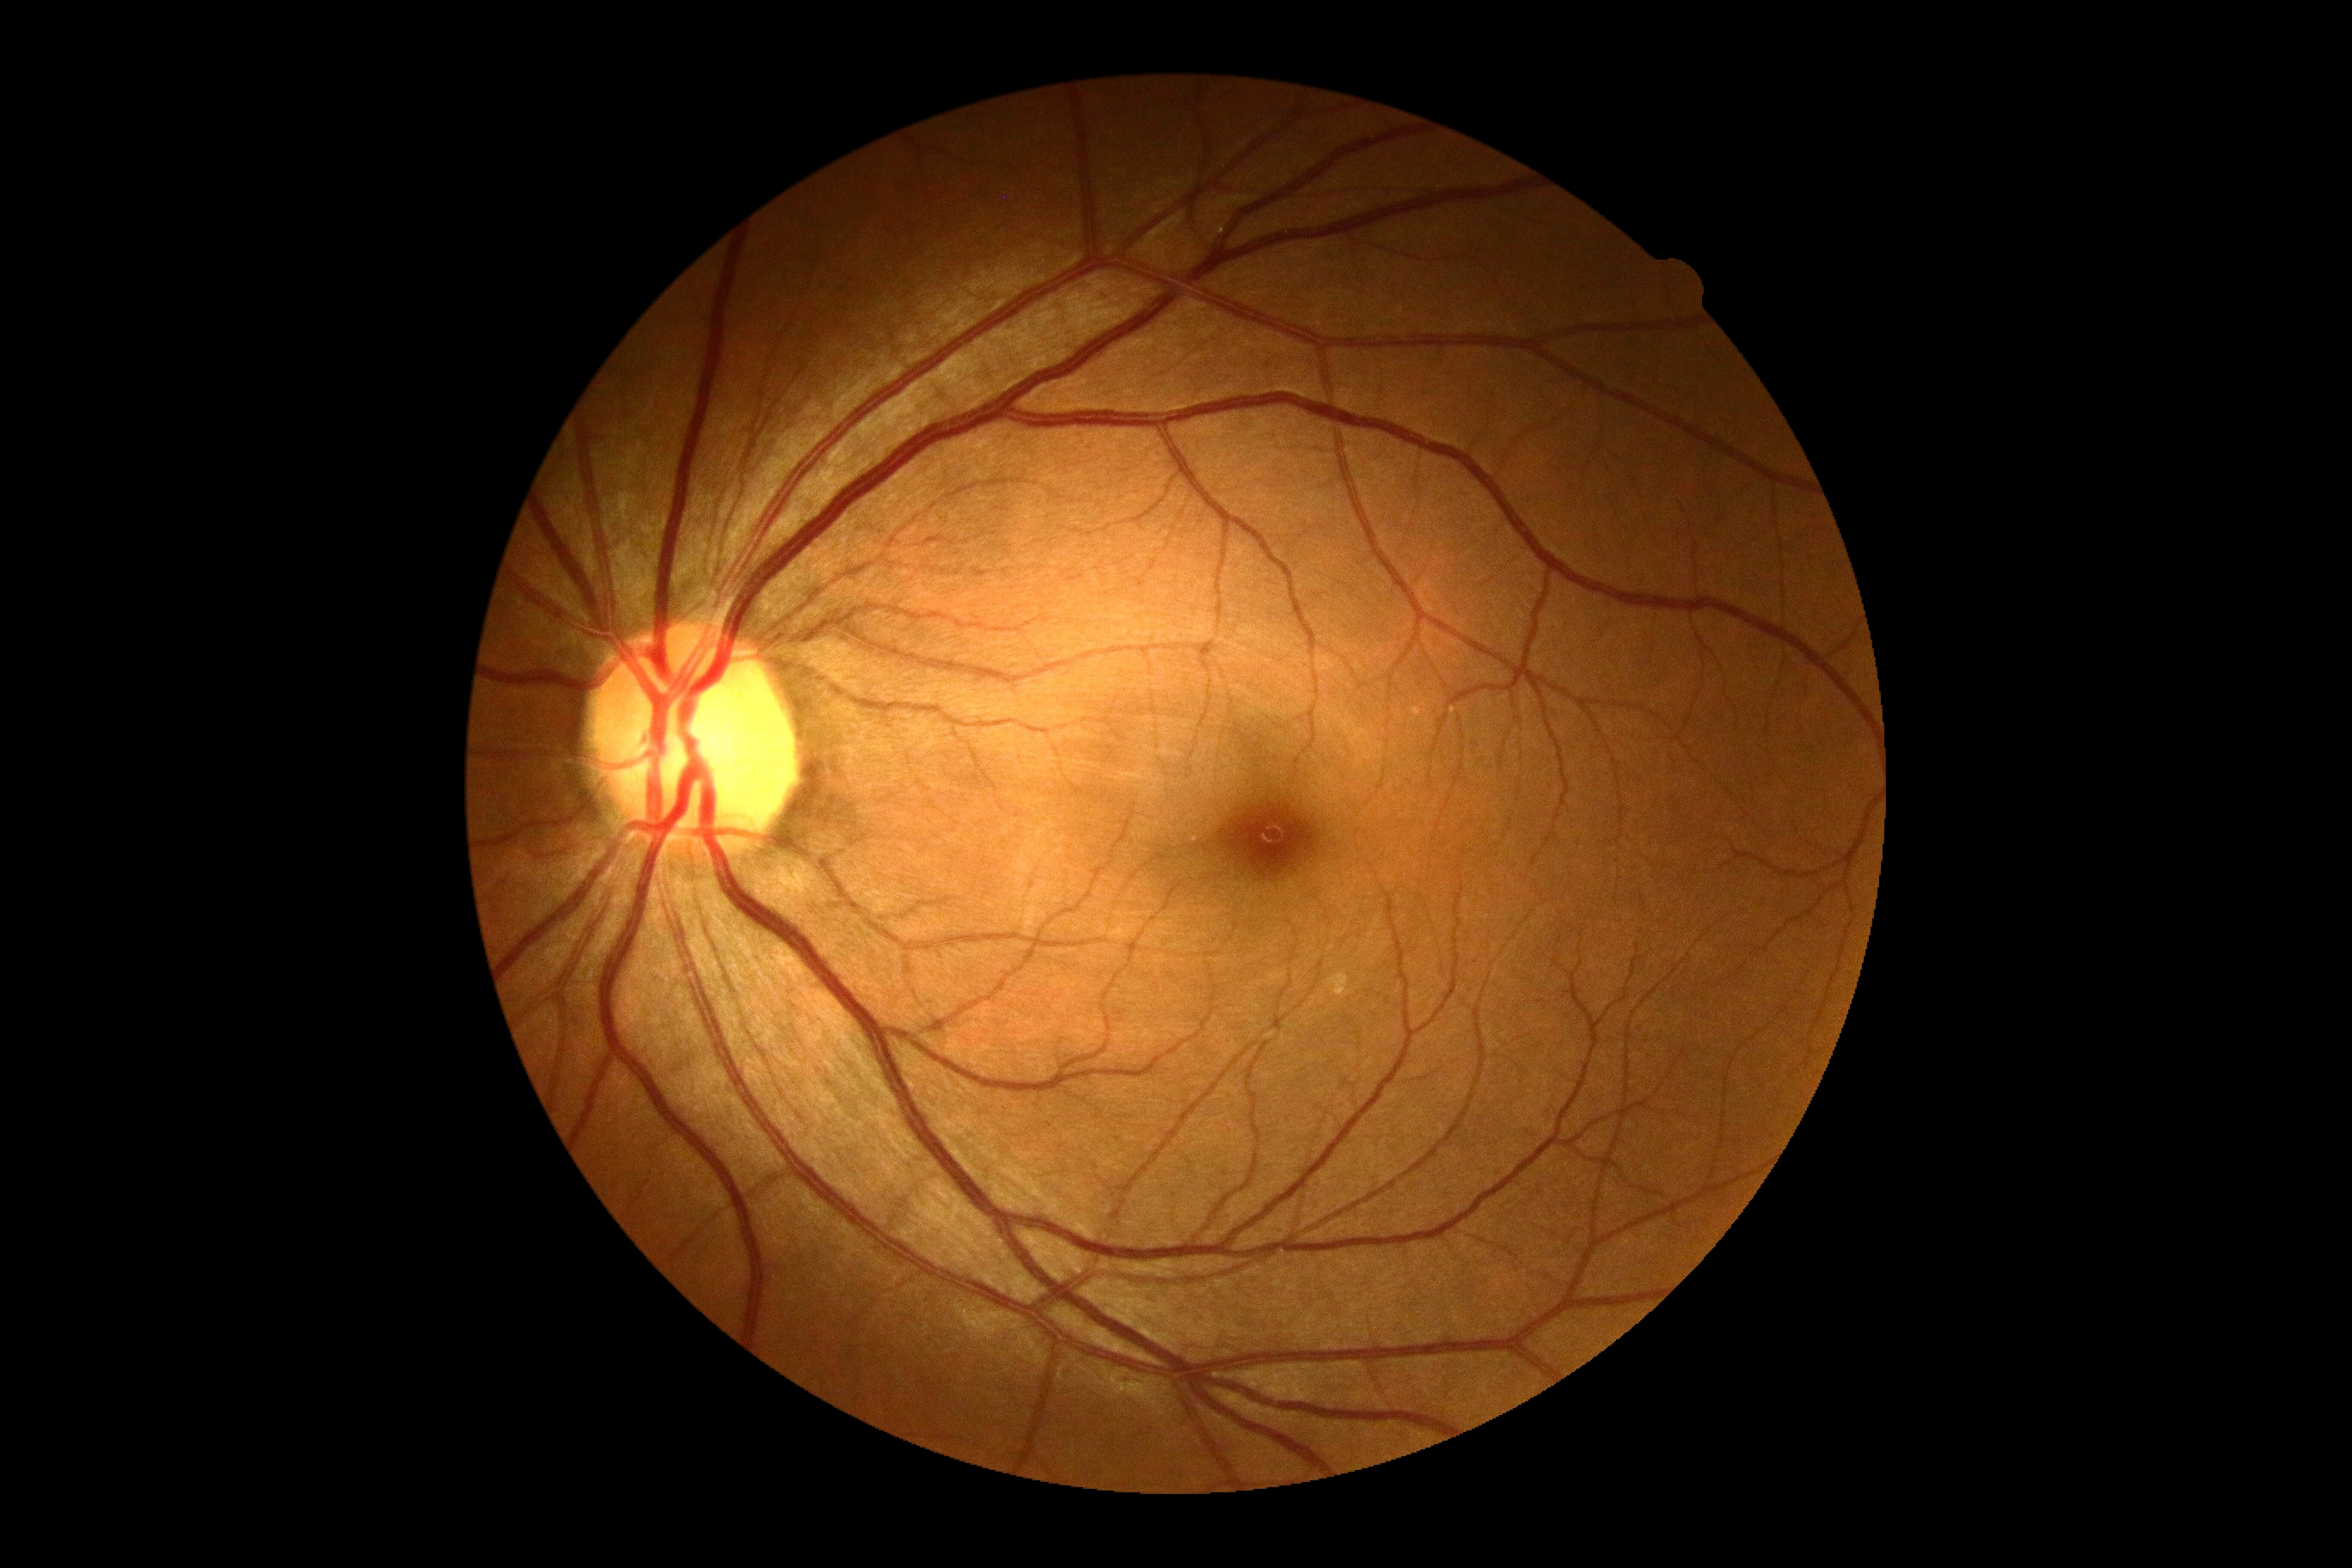
diabetic retinopathy severity: no apparent retinopathy (grade 0)